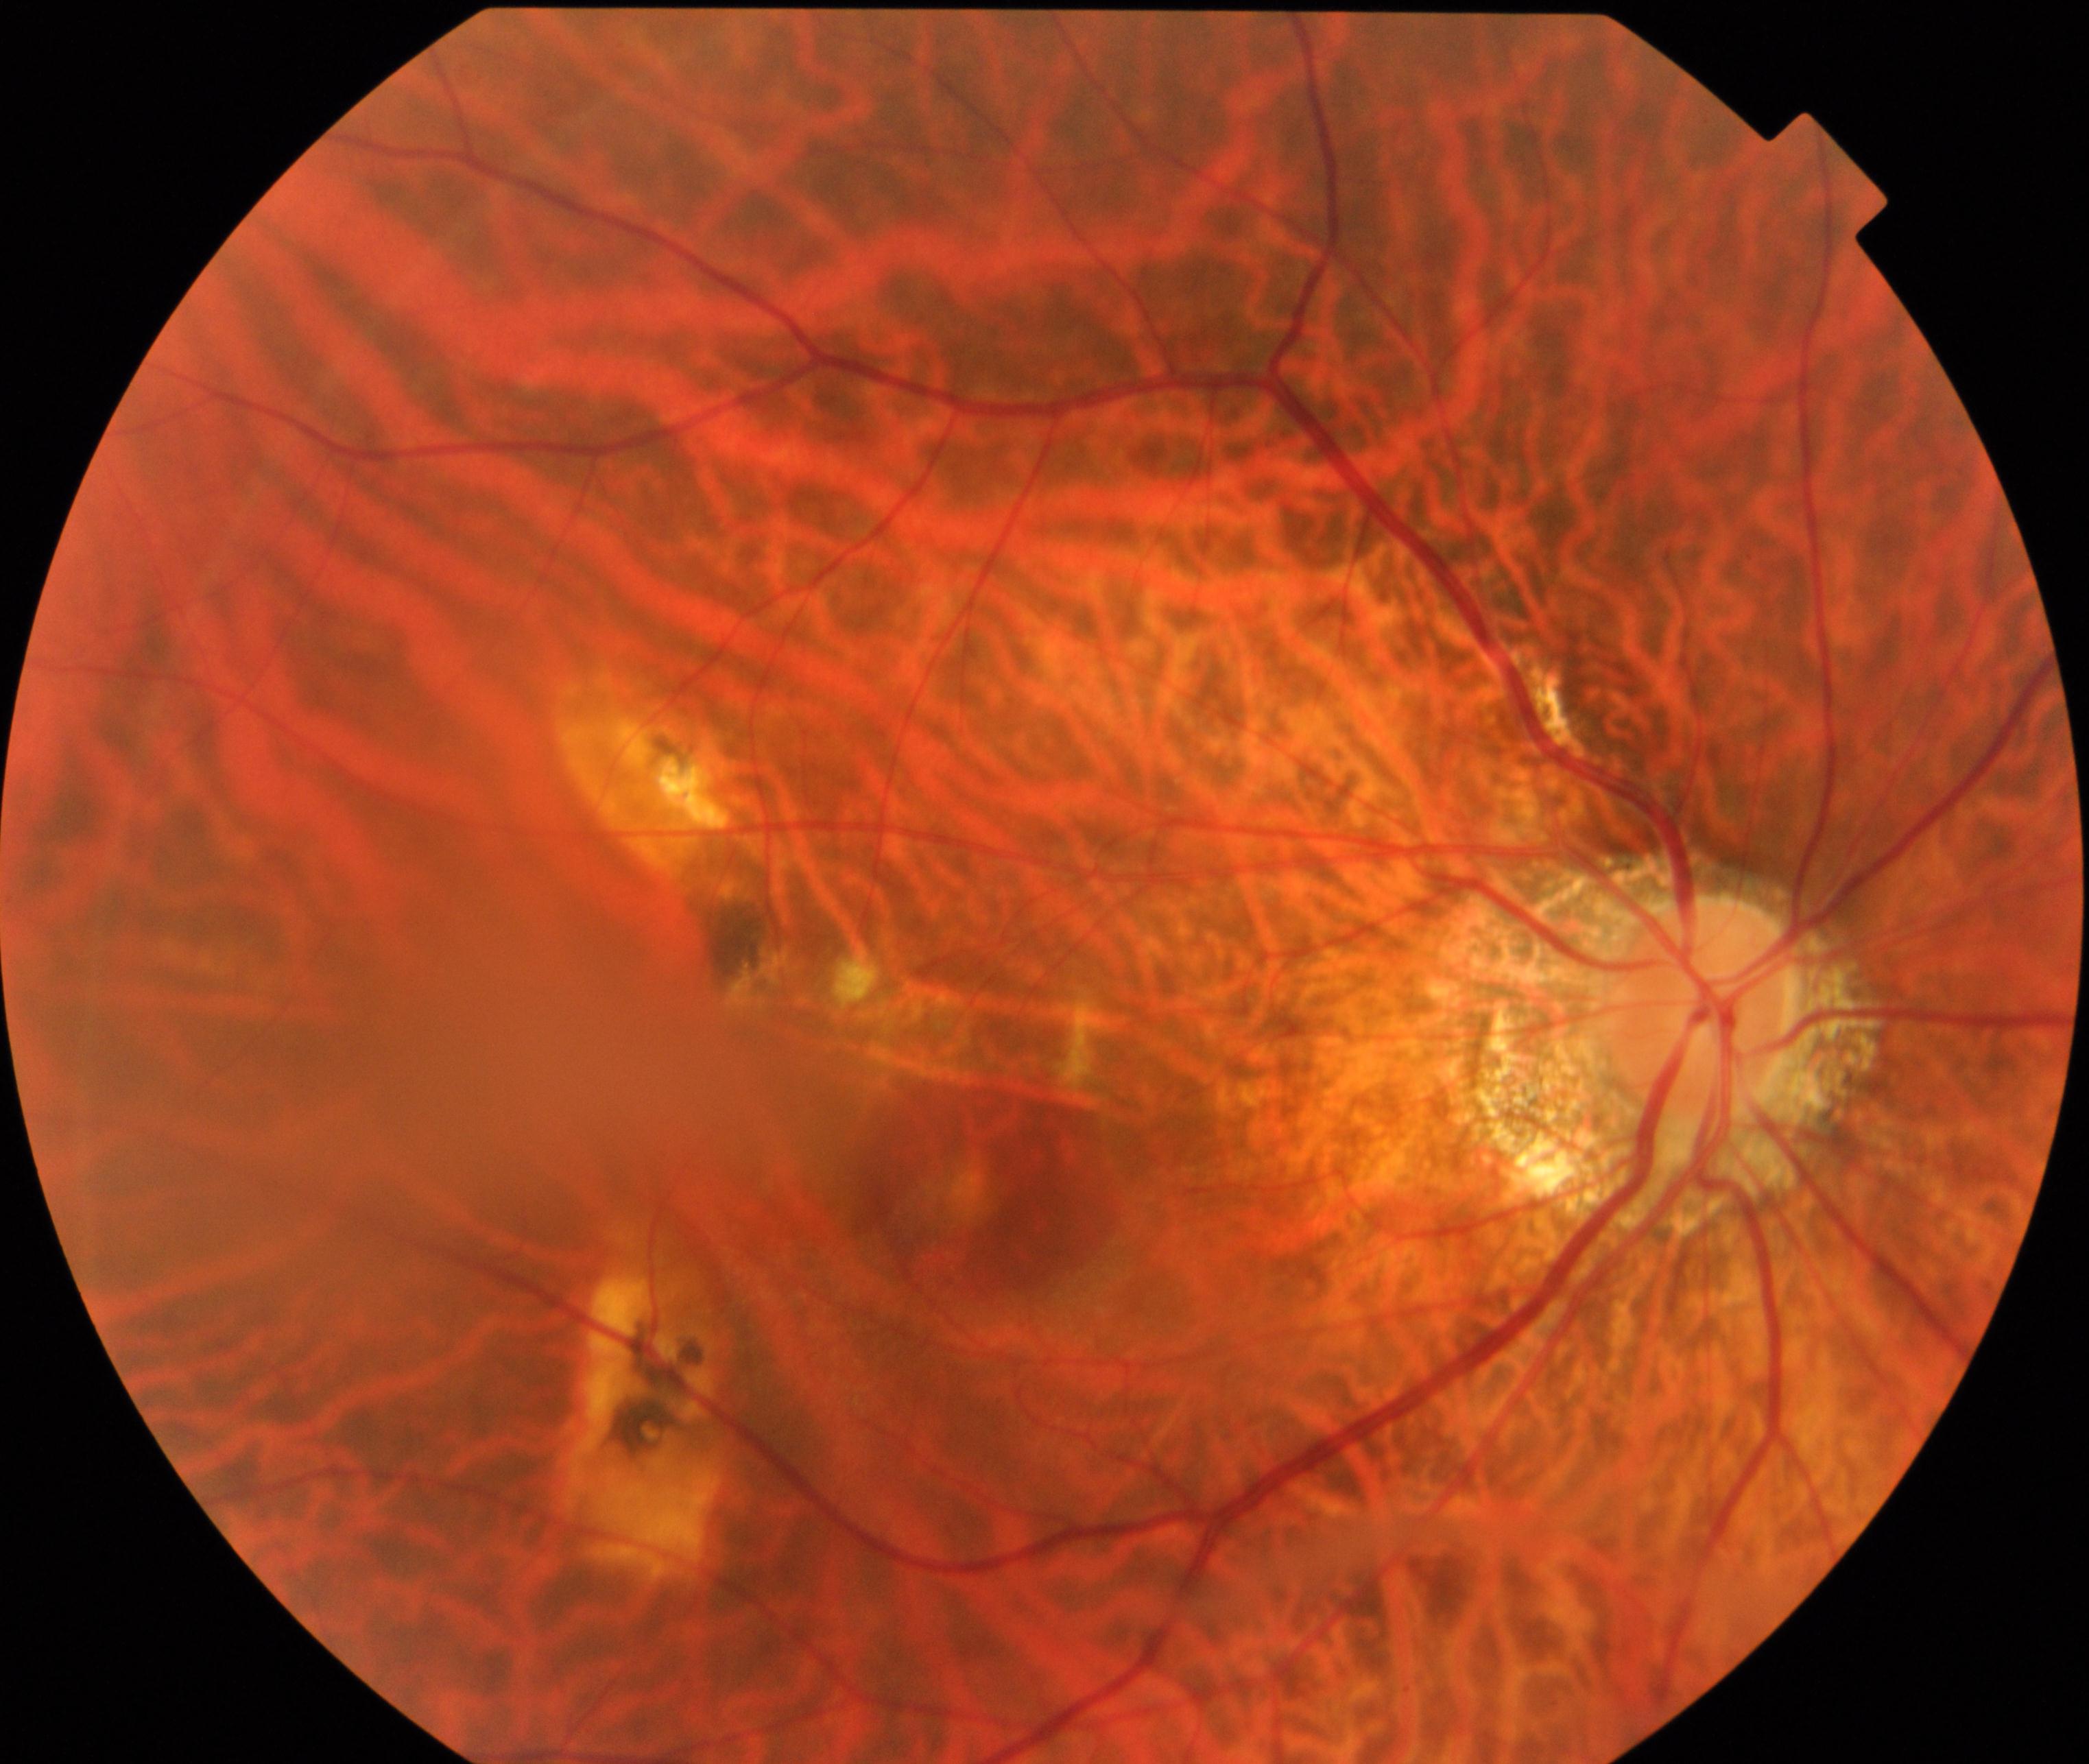
Fundus image consistent with pathological myopia.